2352 x 1568 pixels, 45-degree field of view, CFP
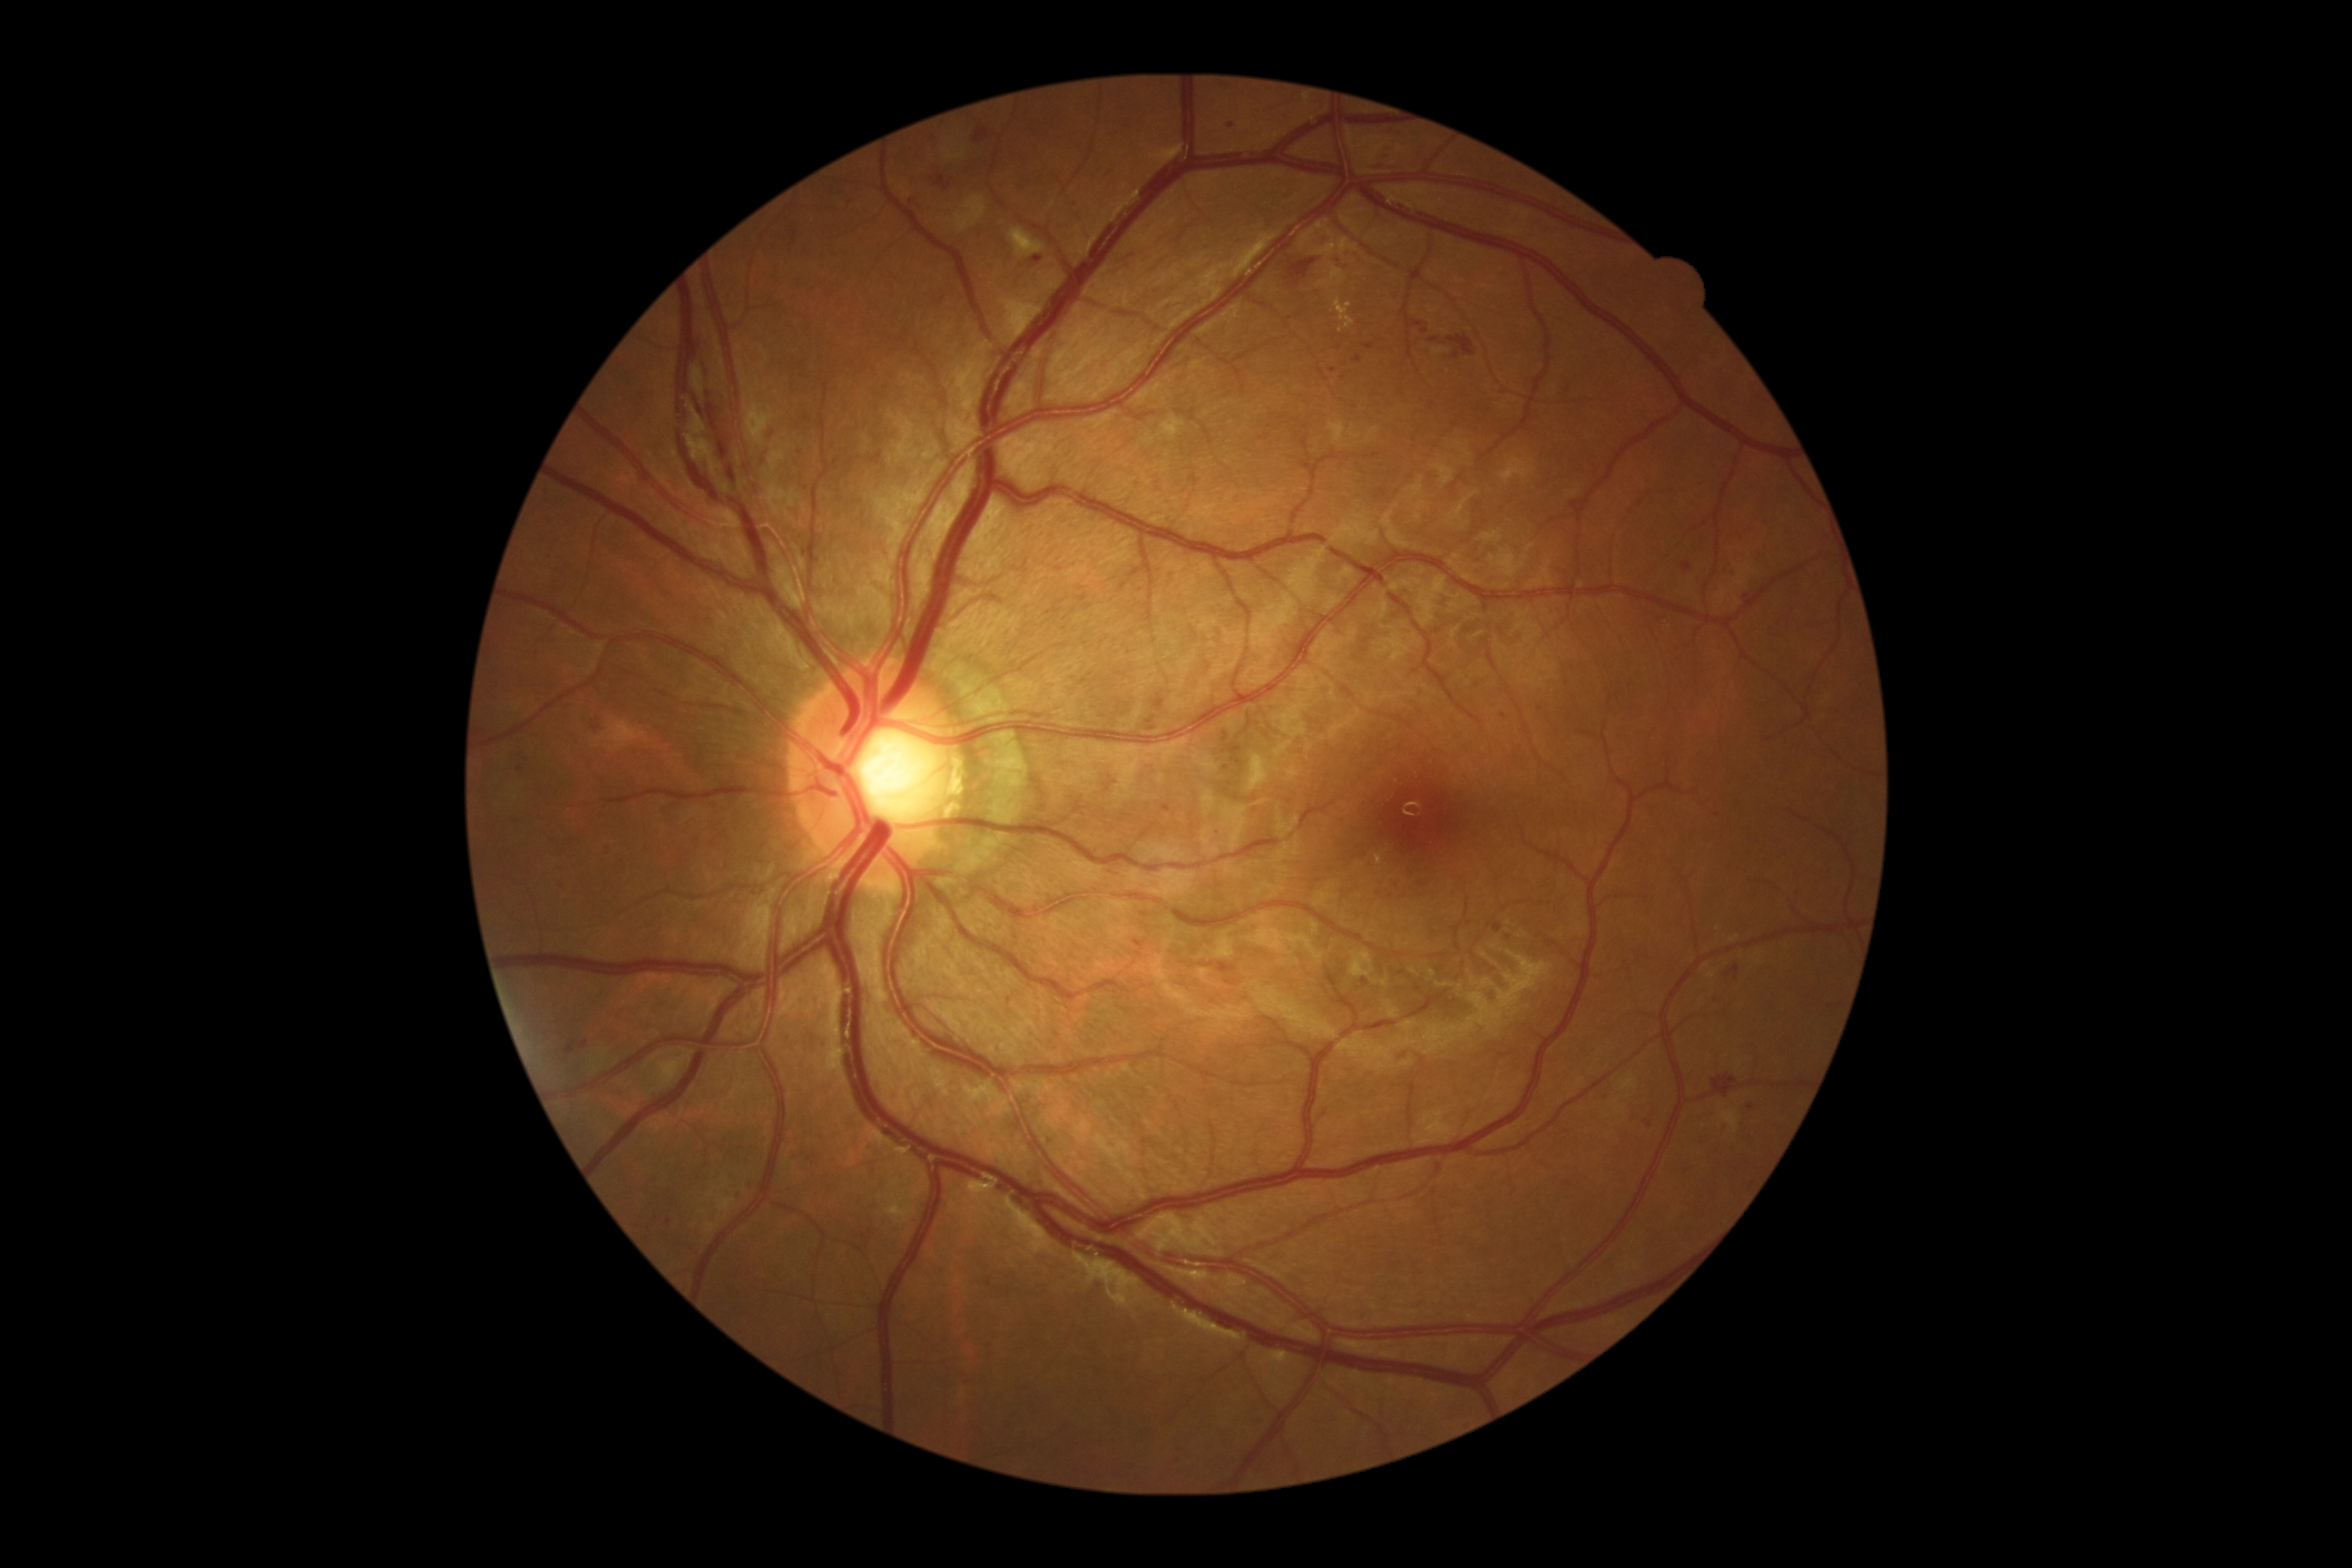

{"dr_grade": "2/4"}